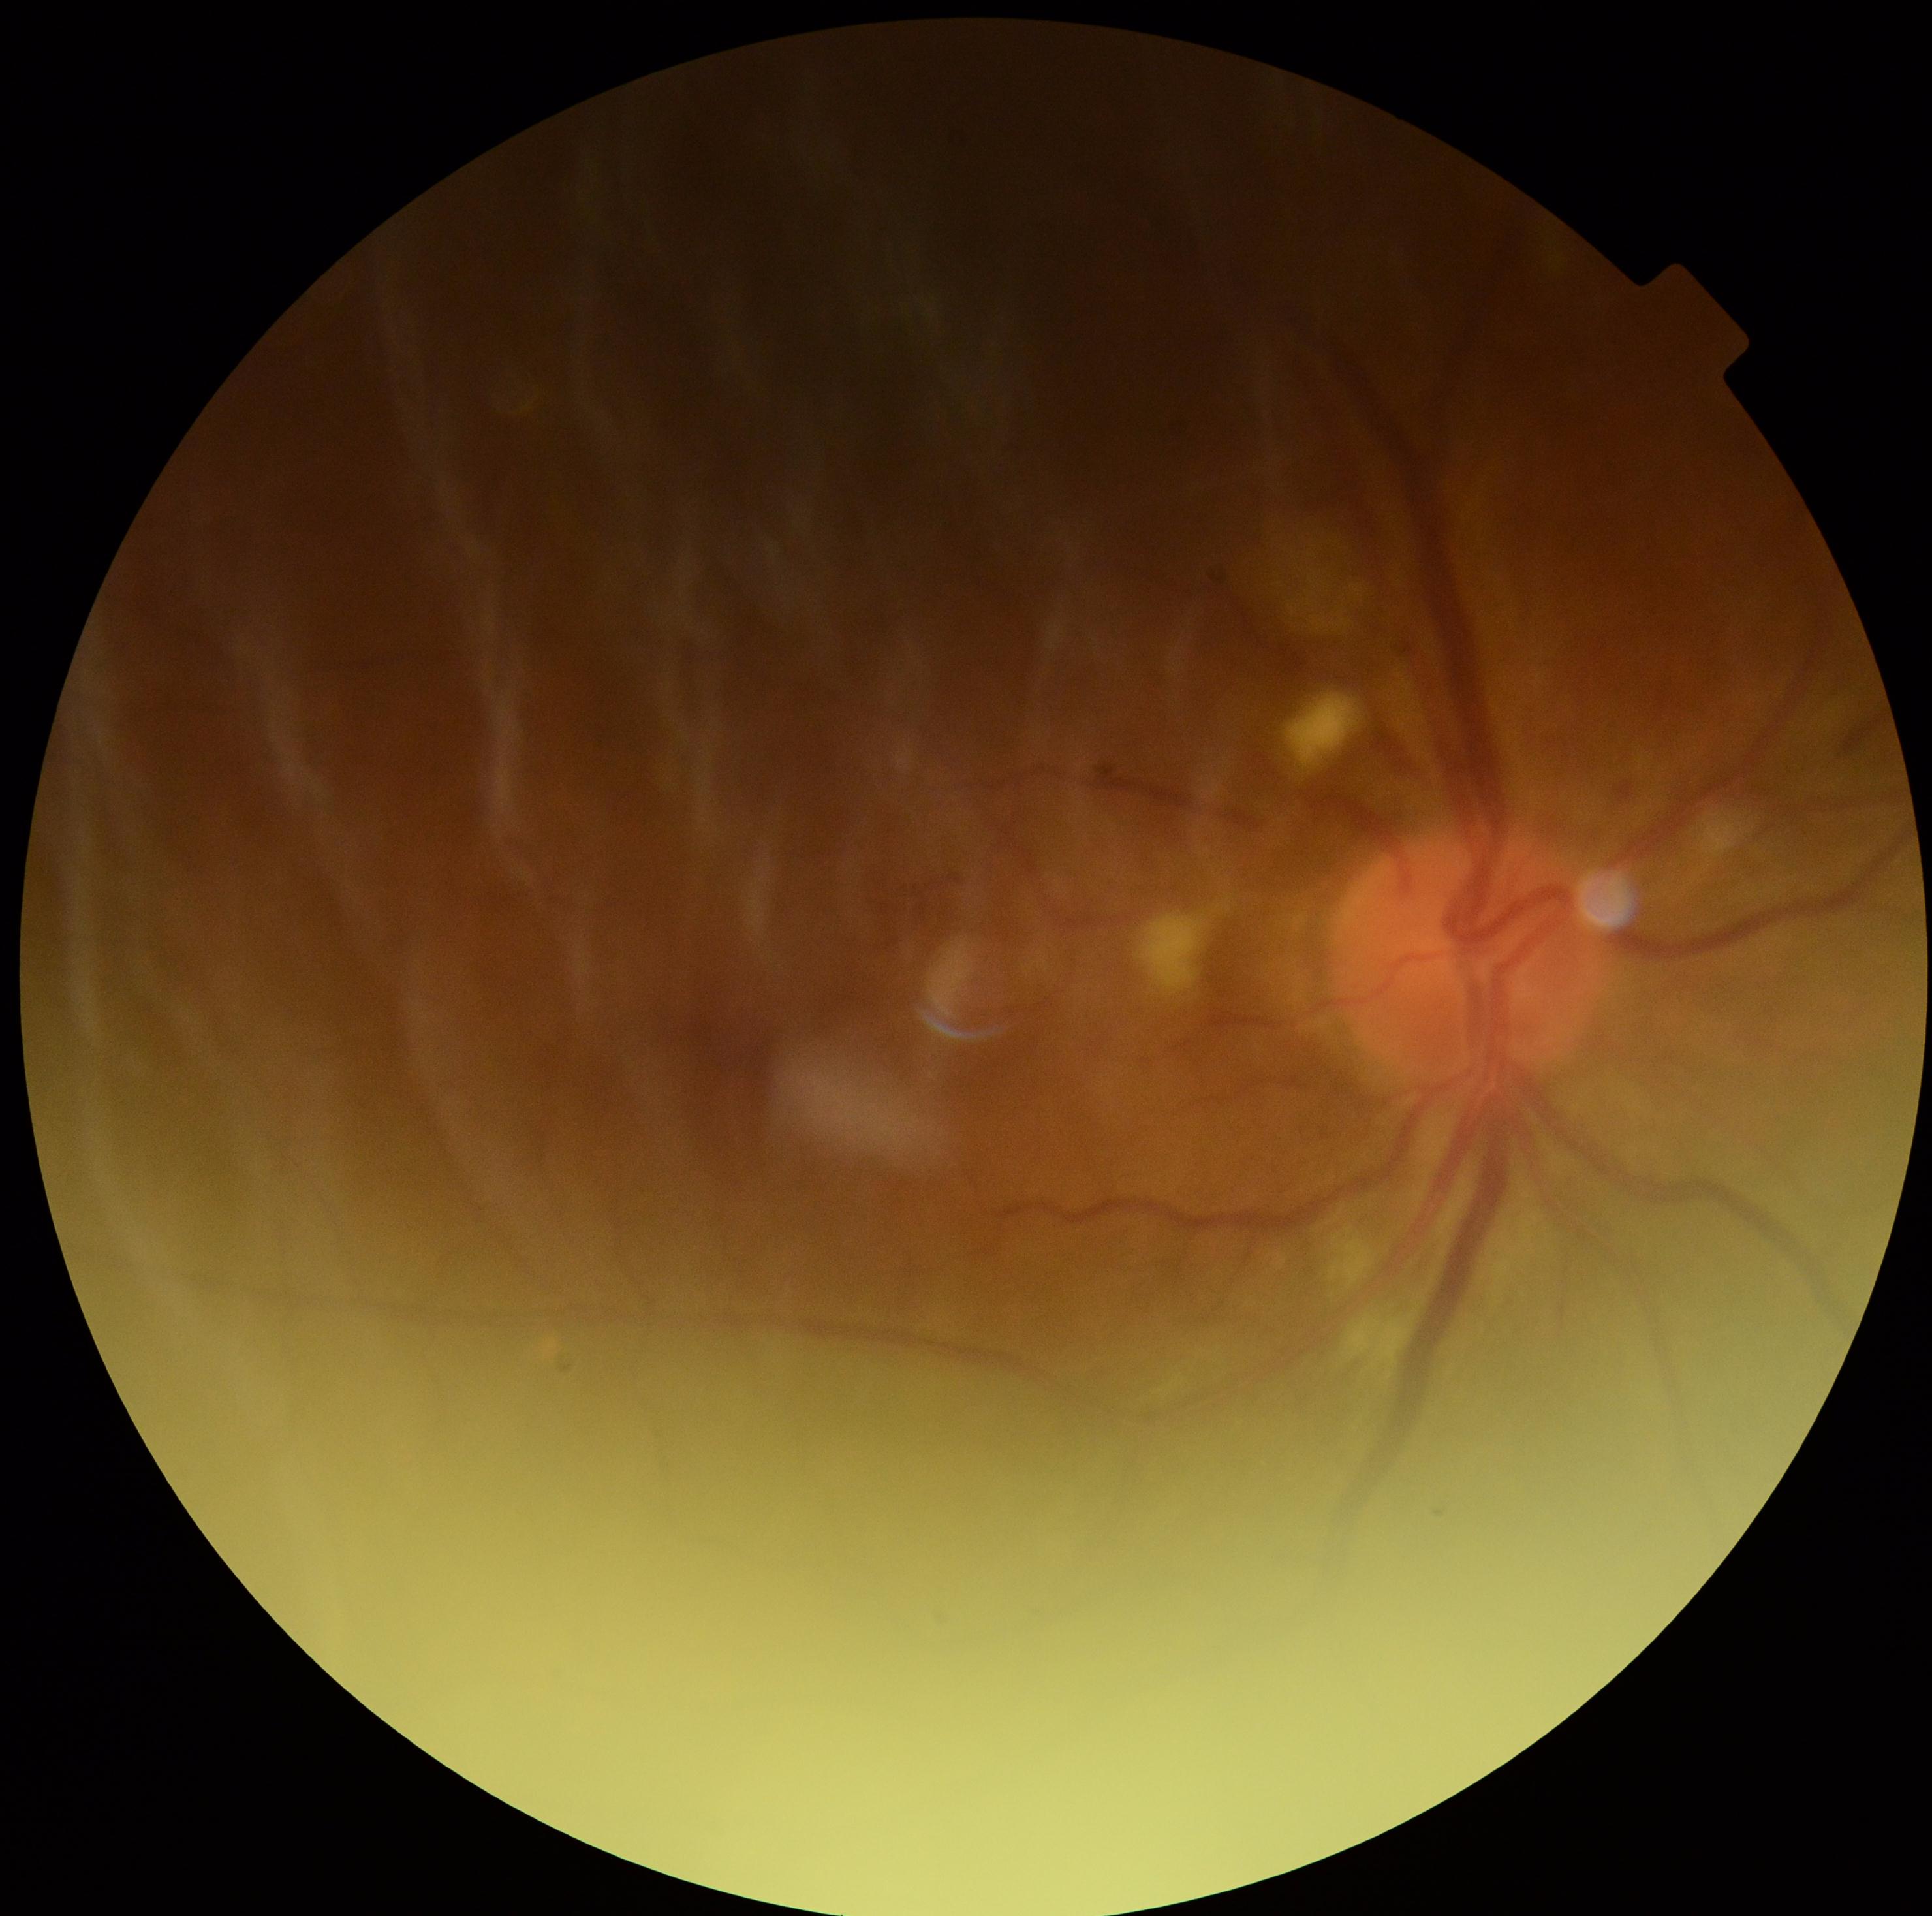

Diabetic retinopathy (DR) is moderate NPDR (grade 2). Disease class: non-proliferative diabetic retinopathy.